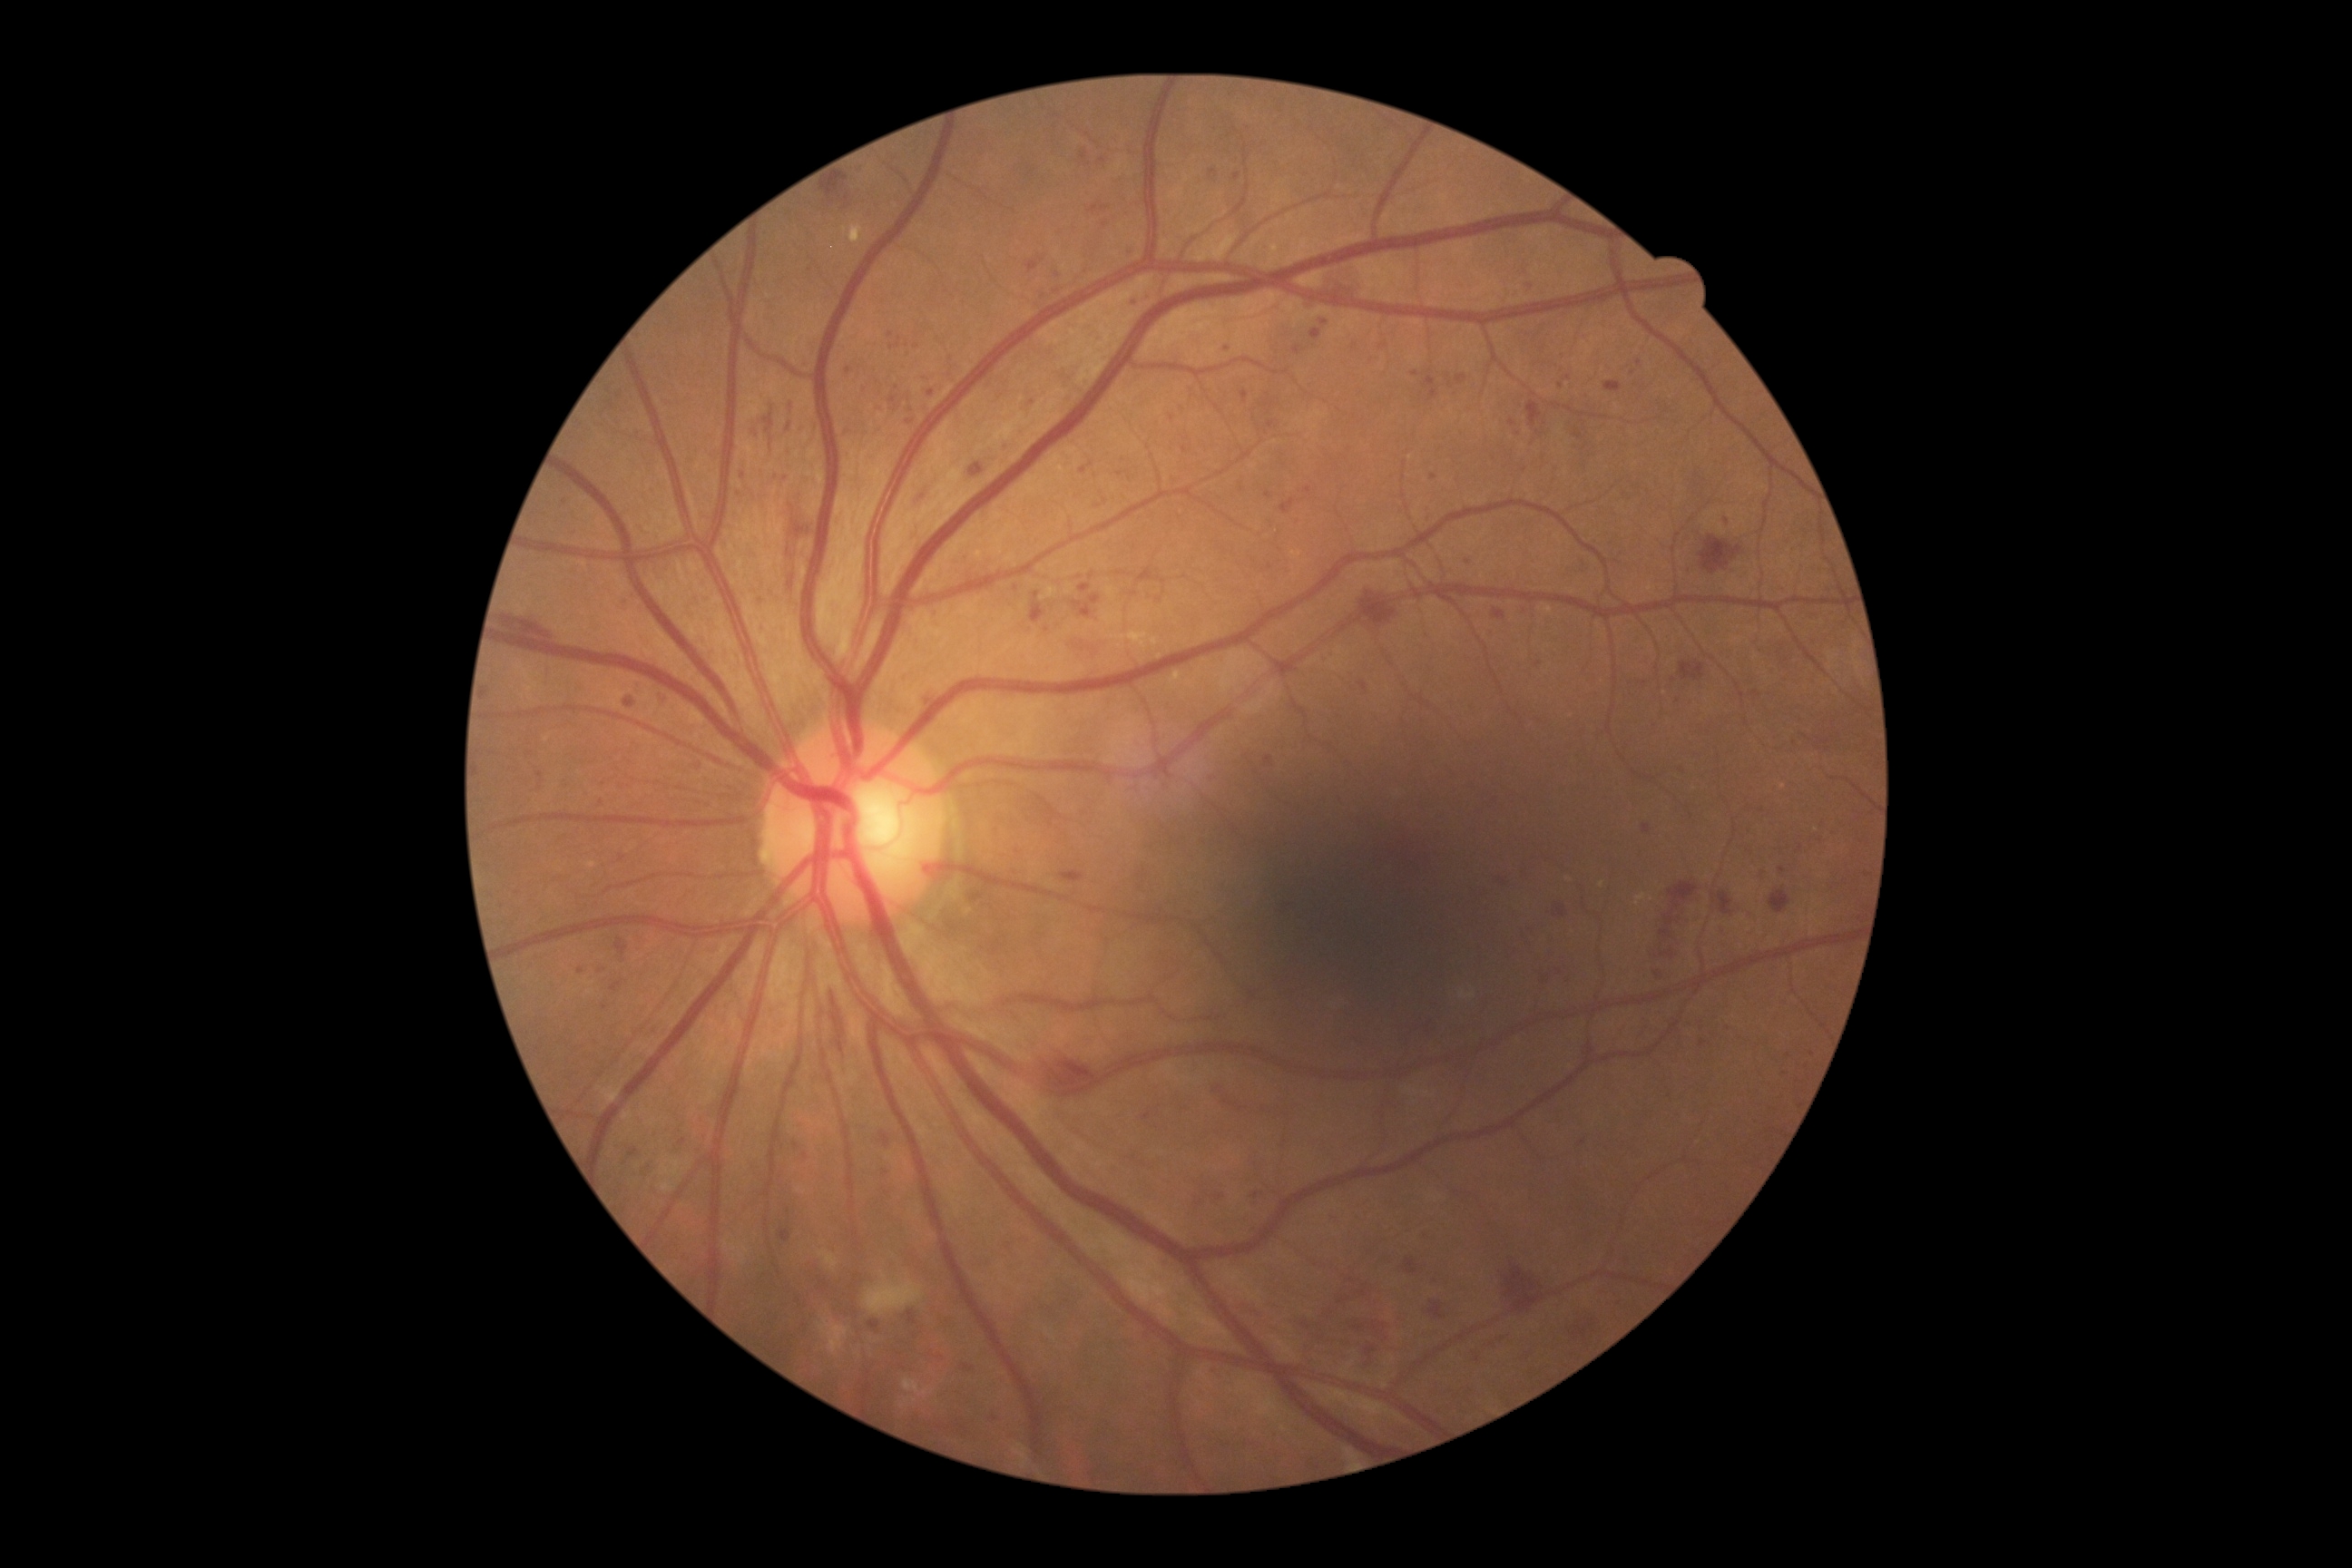
Diabetic retinopathy (DR): grade 3
A subset of detected lesions:
microaneurysms (MAs) (partial): [1781,1070,1787,1079]; [870,1322,879,1329]; [689,760,703,770]; [908,1311,917,1324]; [1752,691,1761,698]; [1073,602,1092,618]; [890,338,901,349]; [1293,346,1302,355]
Small MAs near <pt>1271,425</pt>; <pt>1513,423</pt>; <pt>1383,347</pt>; <pt>1658,975</pt>; <pt>1208,777</pt>; <pt>796,1145</pt>; <pt>1256,1196</pt>; <pt>600,972</pt>; <pt>1539,666</pt>; <pt>1091,465</pt>; <pt>916,347</pt>